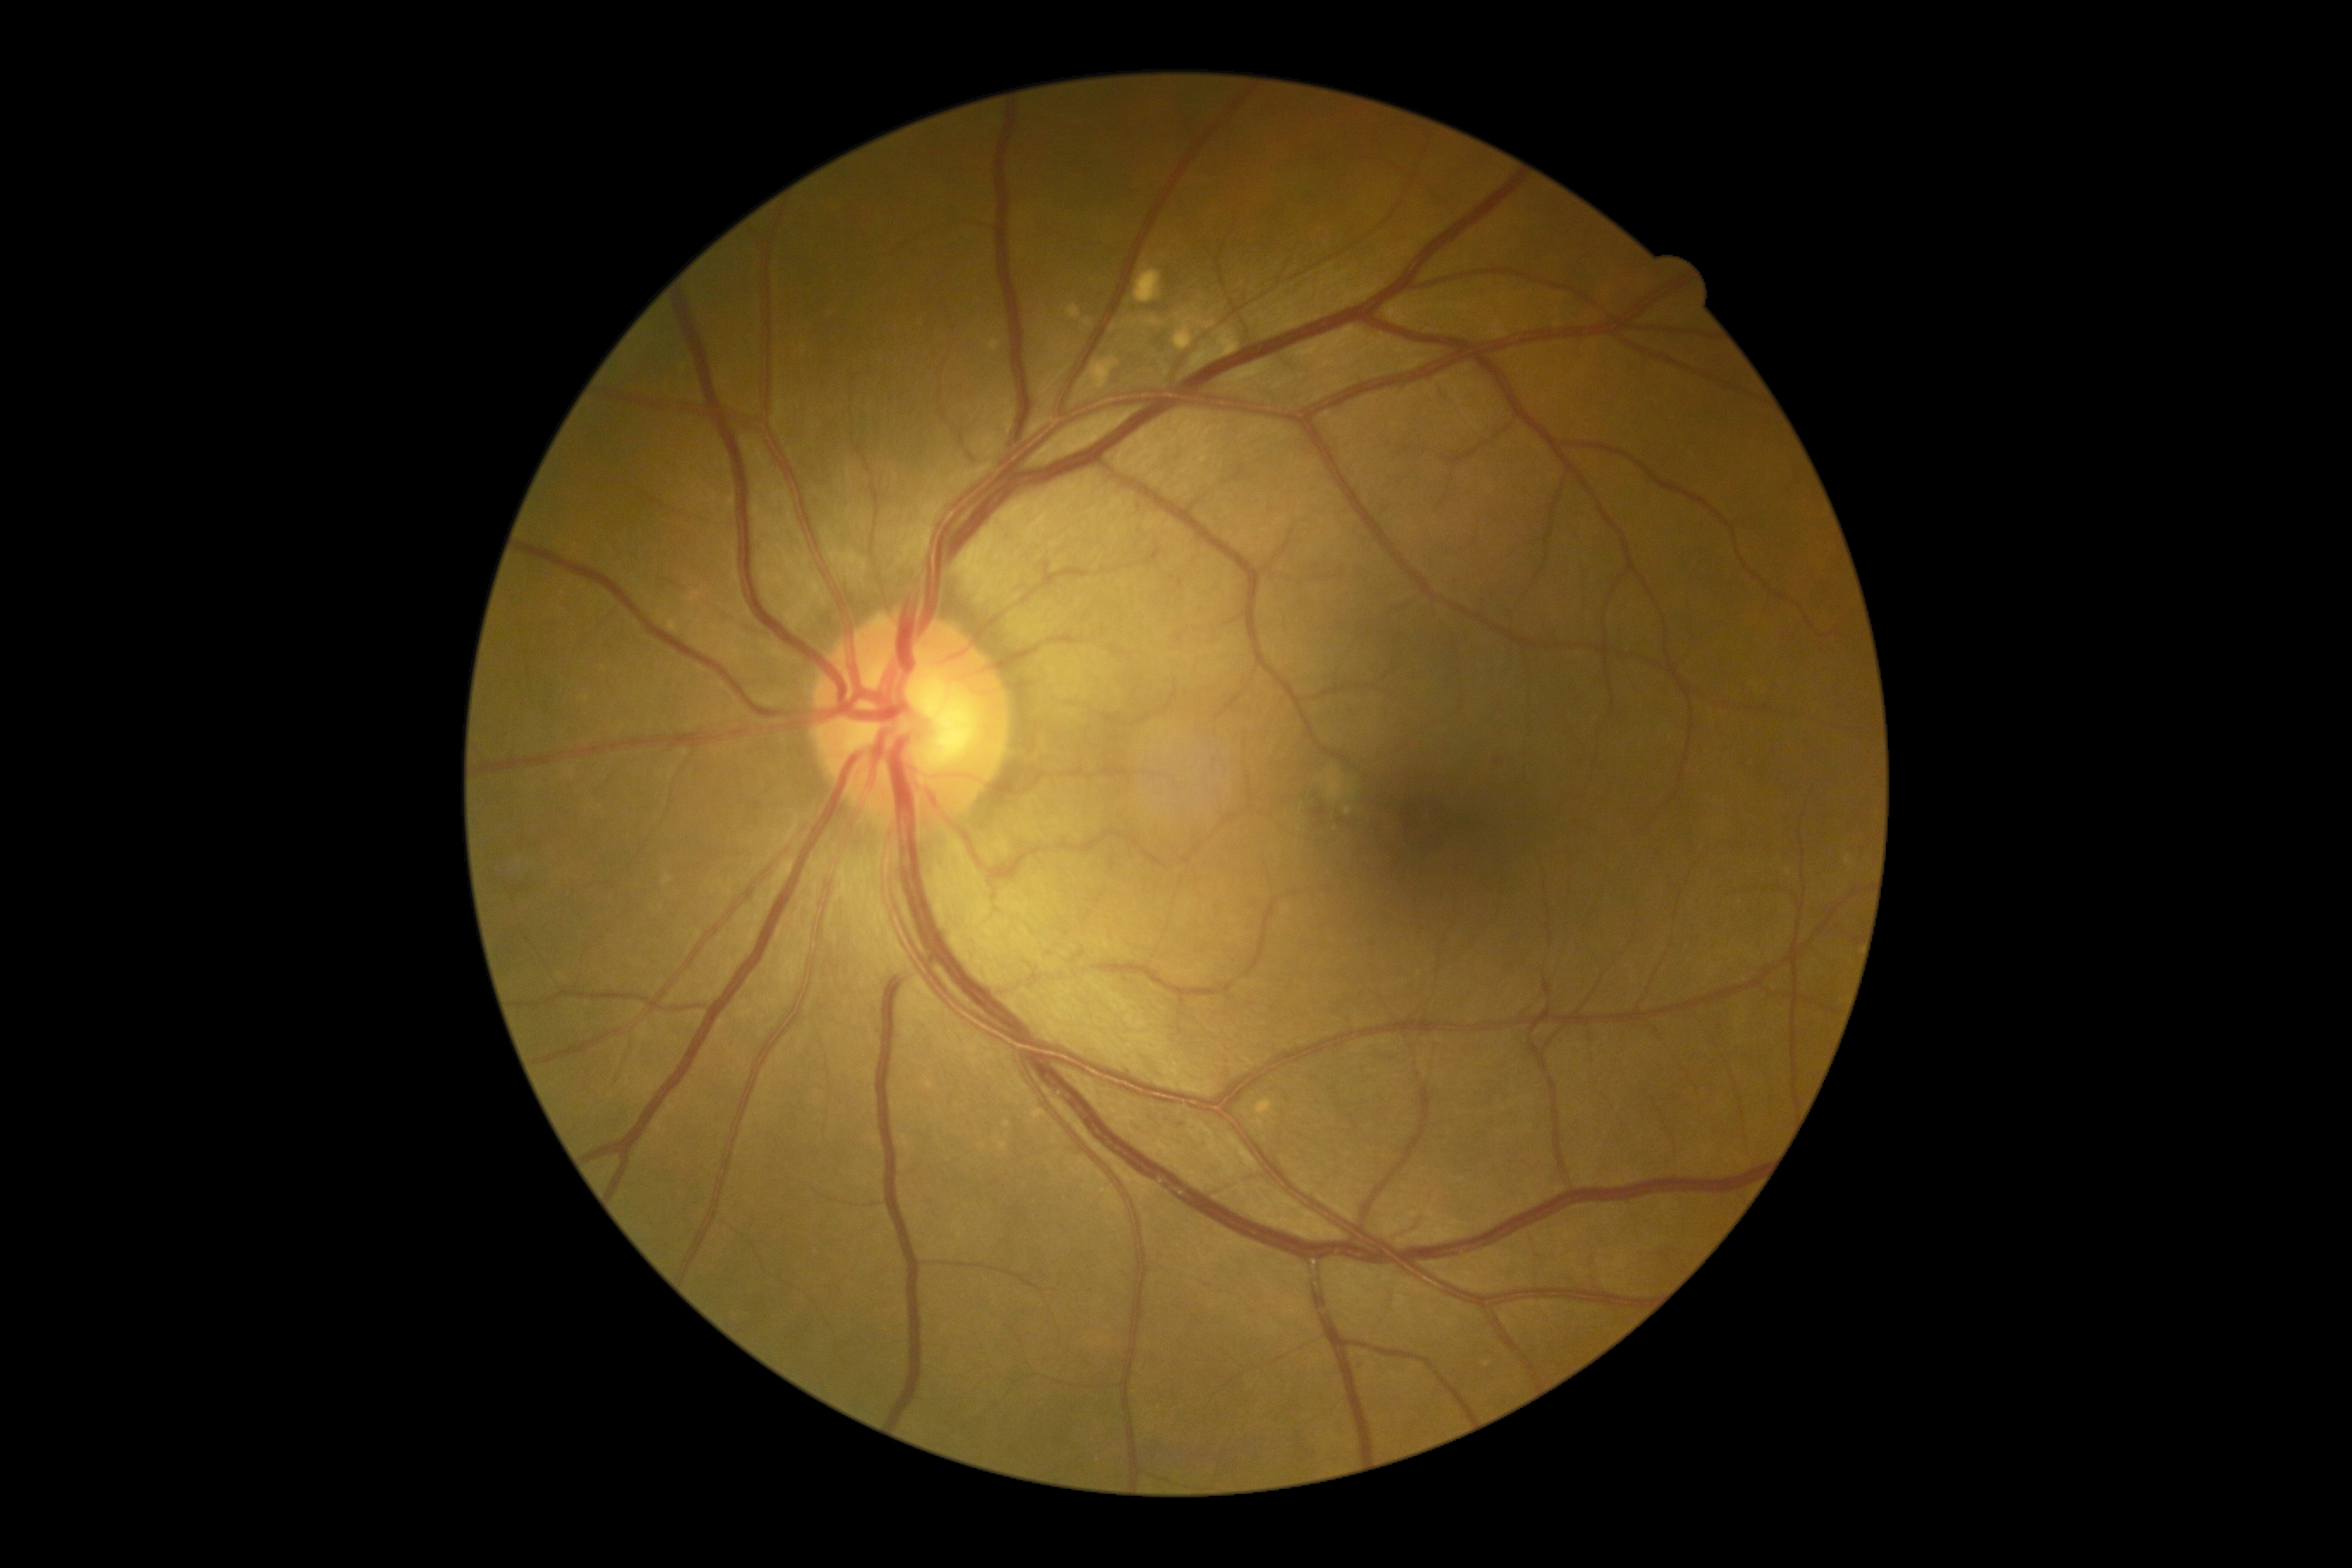

DR grade = mild NPDR (1) — presence of microaneurysms only.